Pediatric retinal photograph (wide-field). Acquired on the Clarity RetCam 3
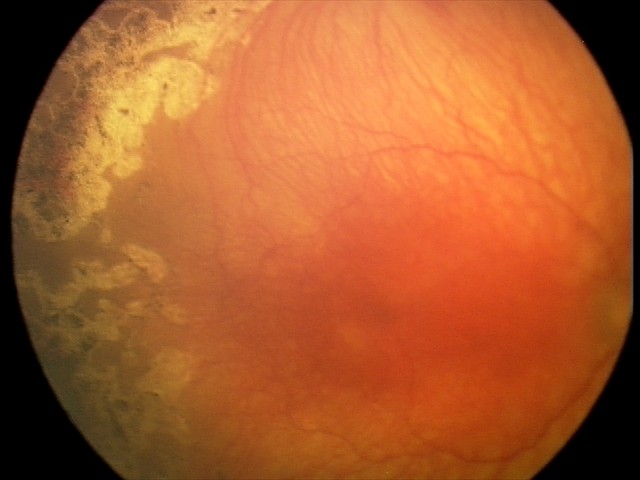
Assessment: plus disease; A-ROP (aggressive ROP) — rapidly progressive severe ROP with prominent plus disease, often without classic stage progression.